FOV: 45 degrees
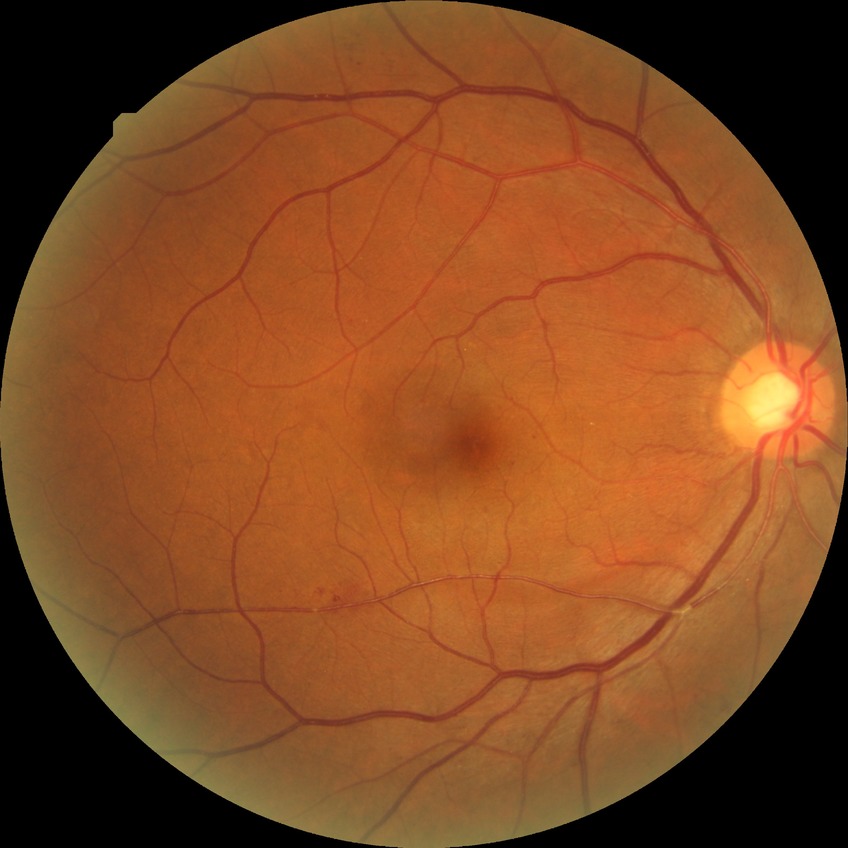
Annotations:
– DR class: non-proliferative diabetic retinopathy
– diabetic retinopathy (DR): SDR (simple diabetic retinopathy)